45° field of view. 2212x1659
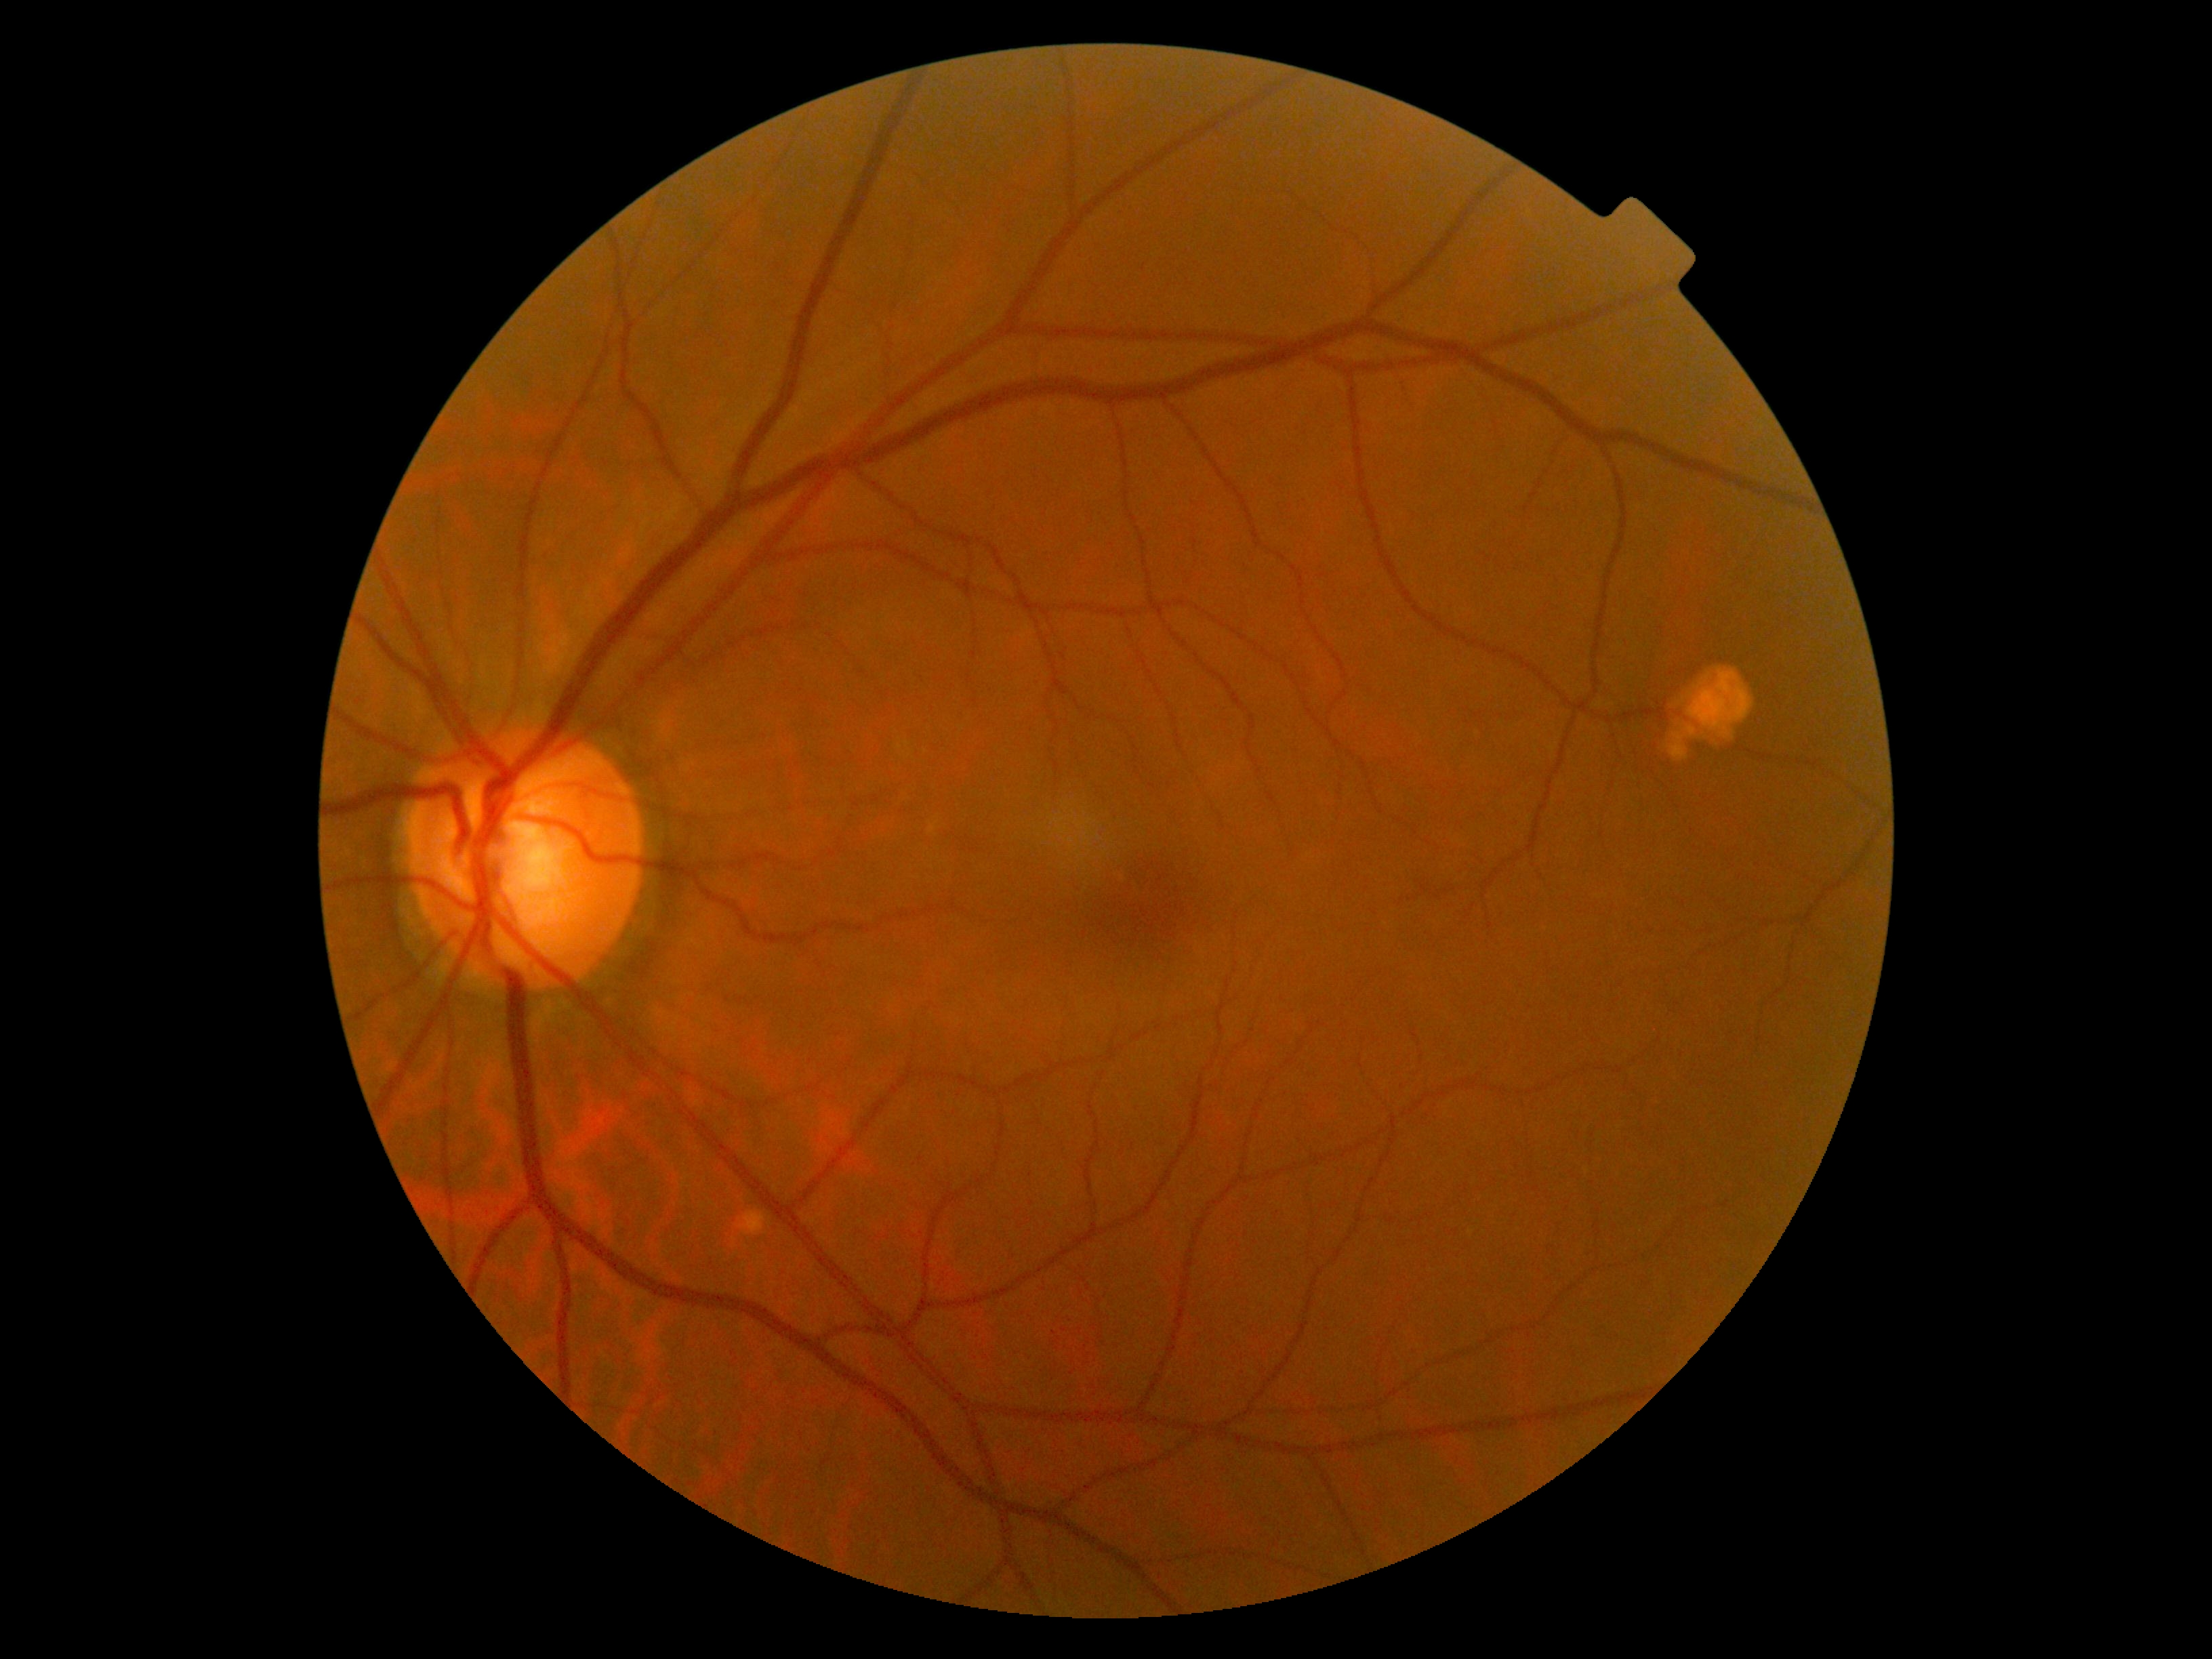 DR = grade 0 (no apparent retinopathy).